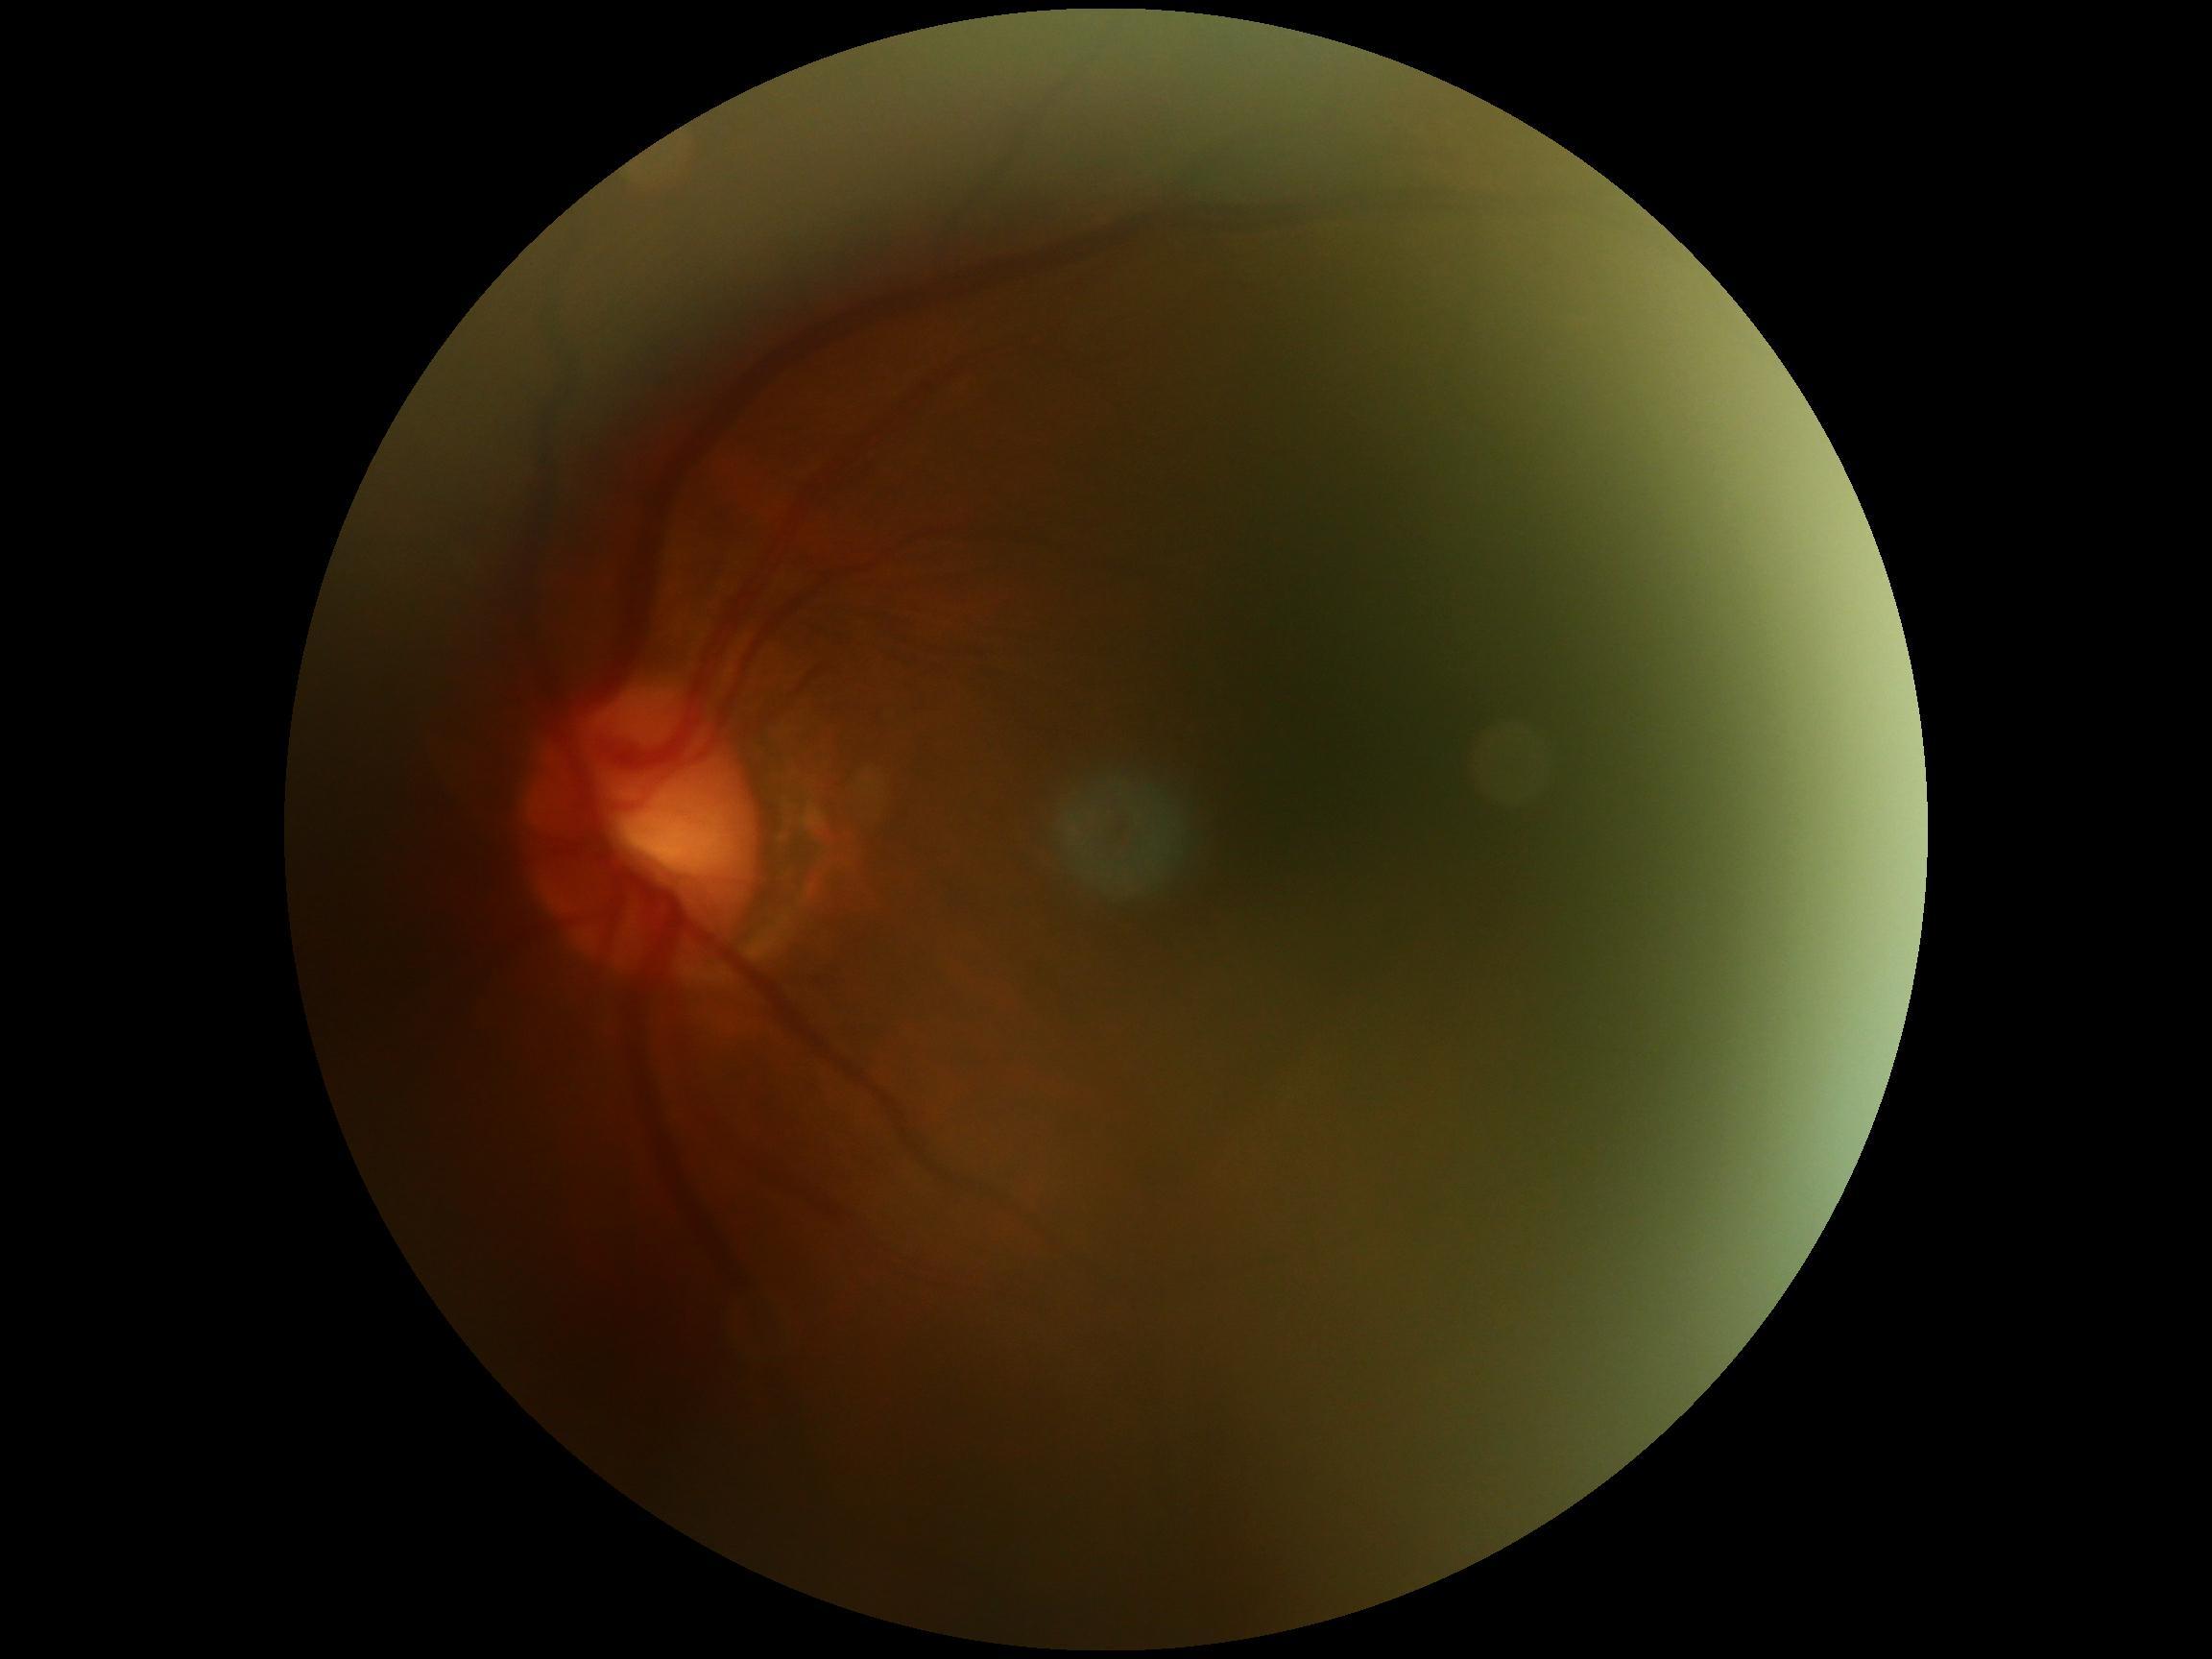 image quality@insufficient; DR@ungradable.